Color fundus image:
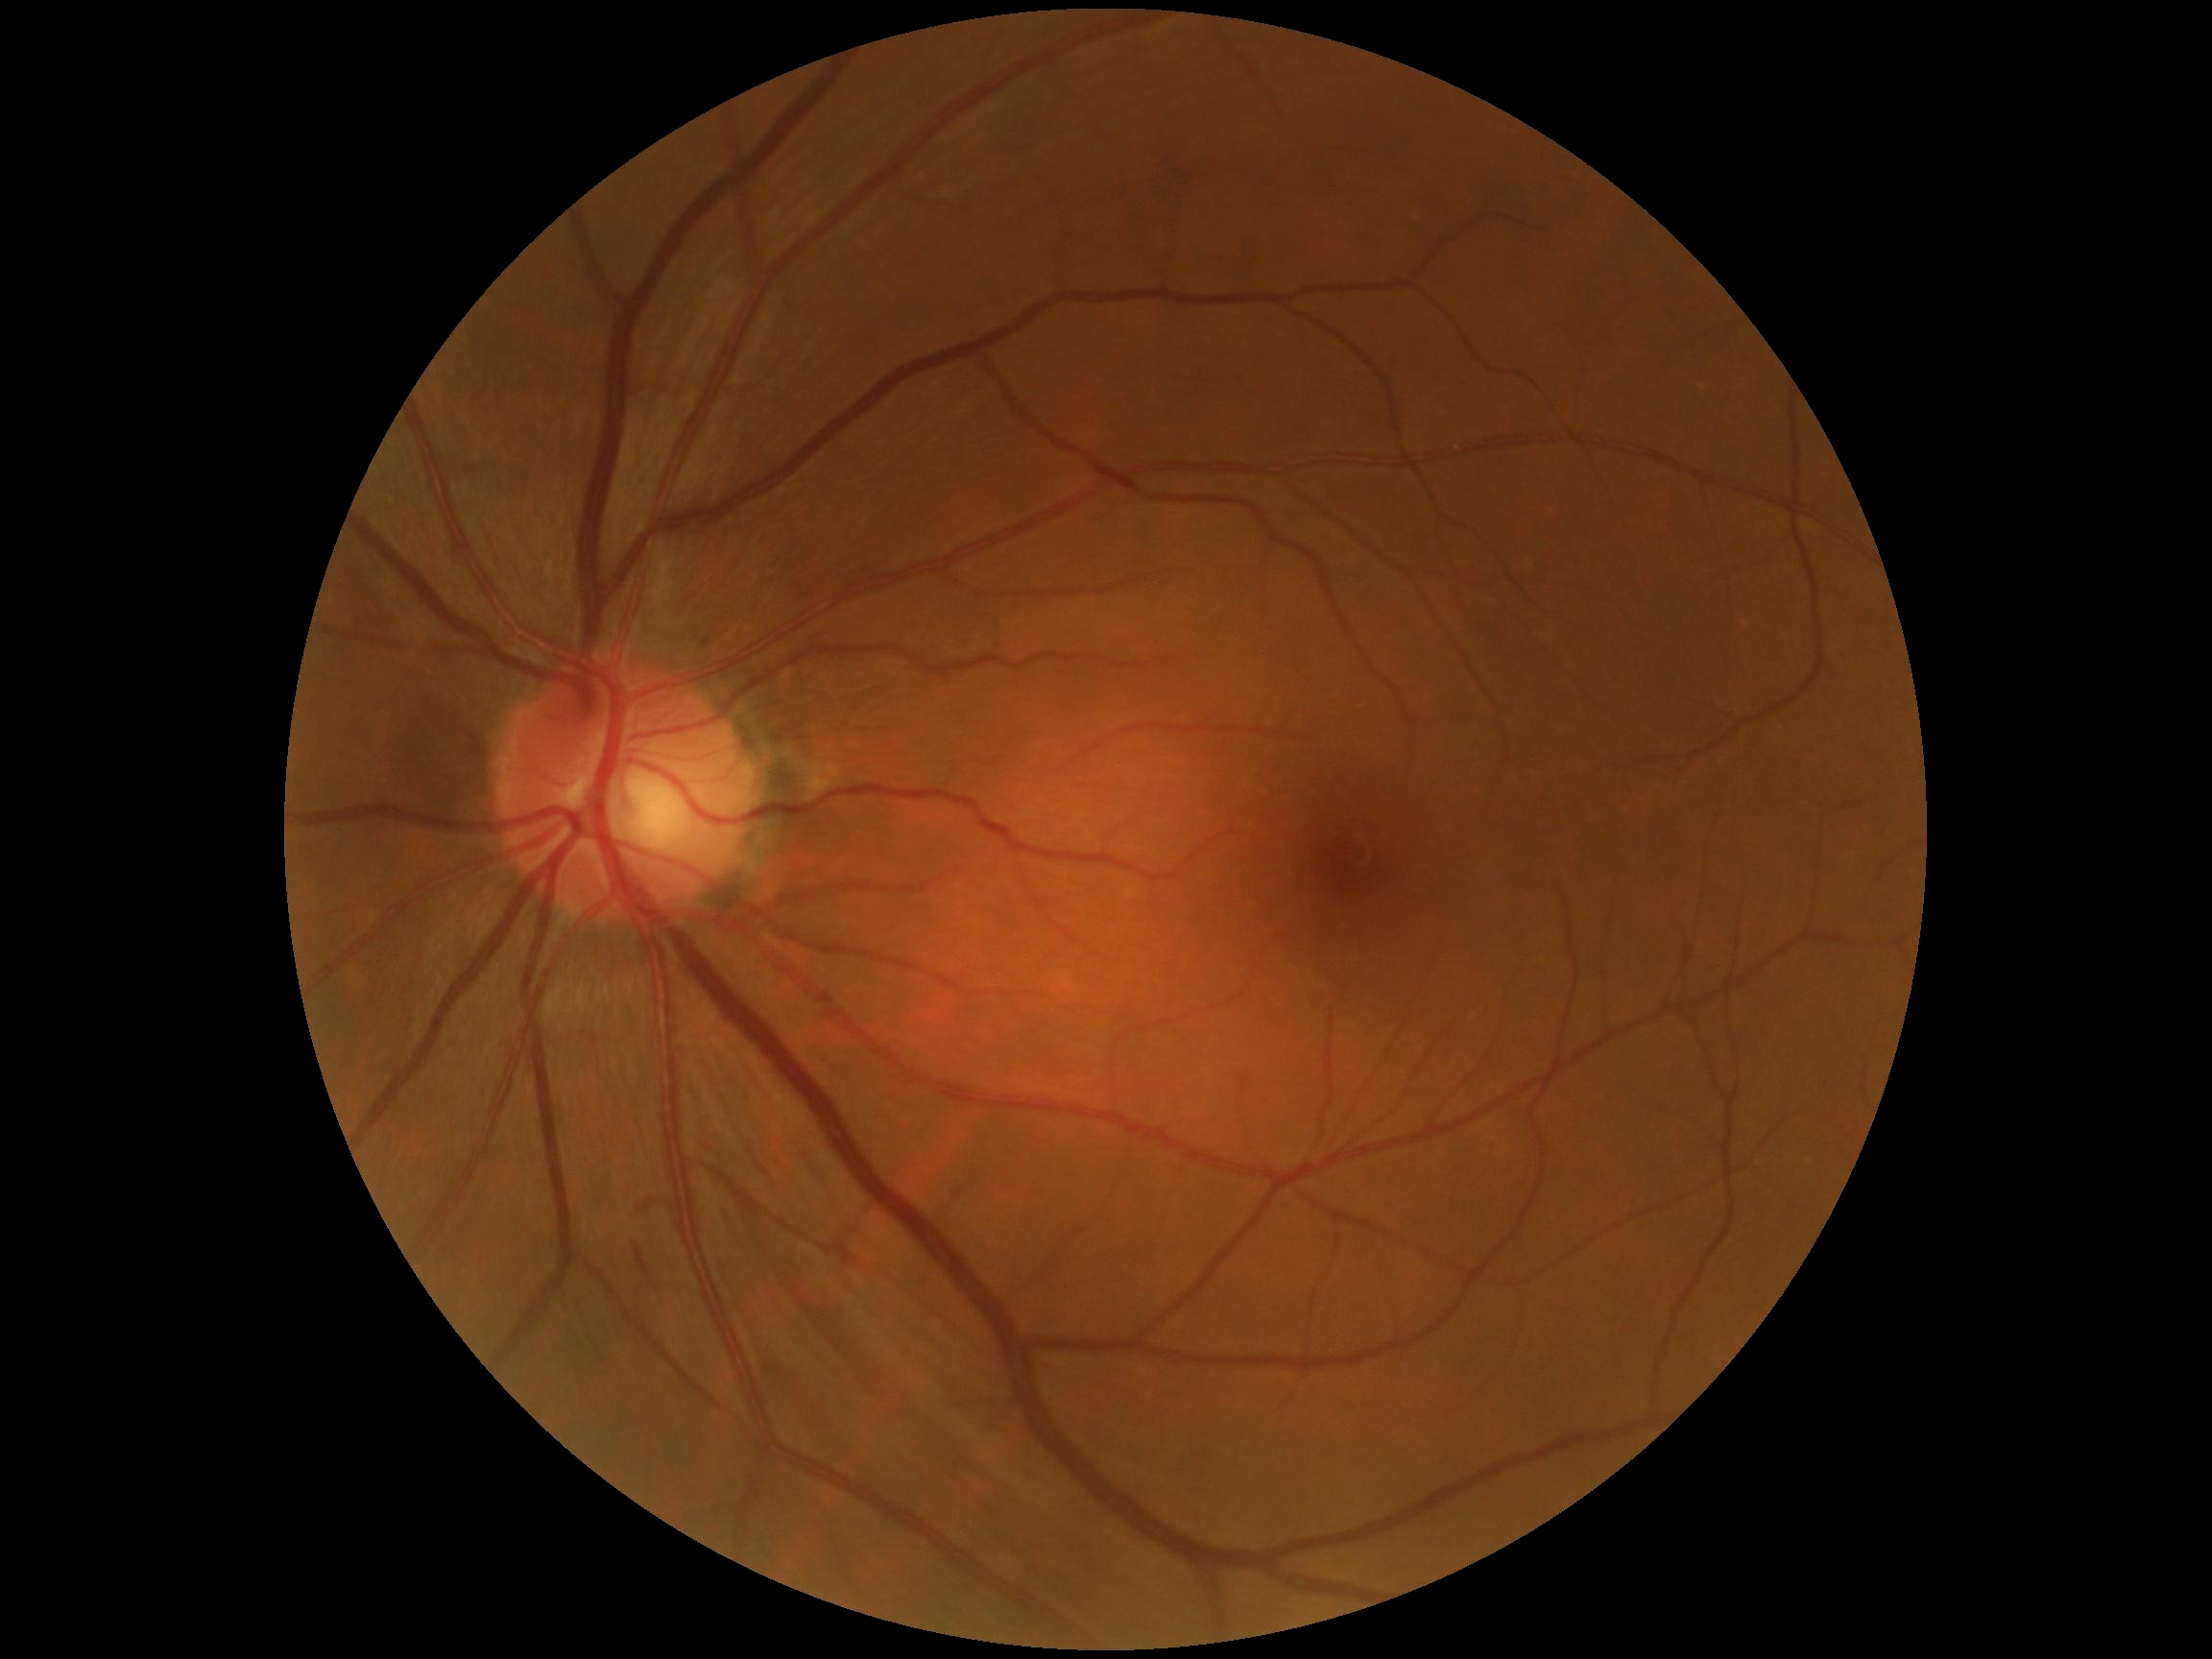
Diabetic retinopathy is grade 2.